45-degree field of view · color fundus photograph:
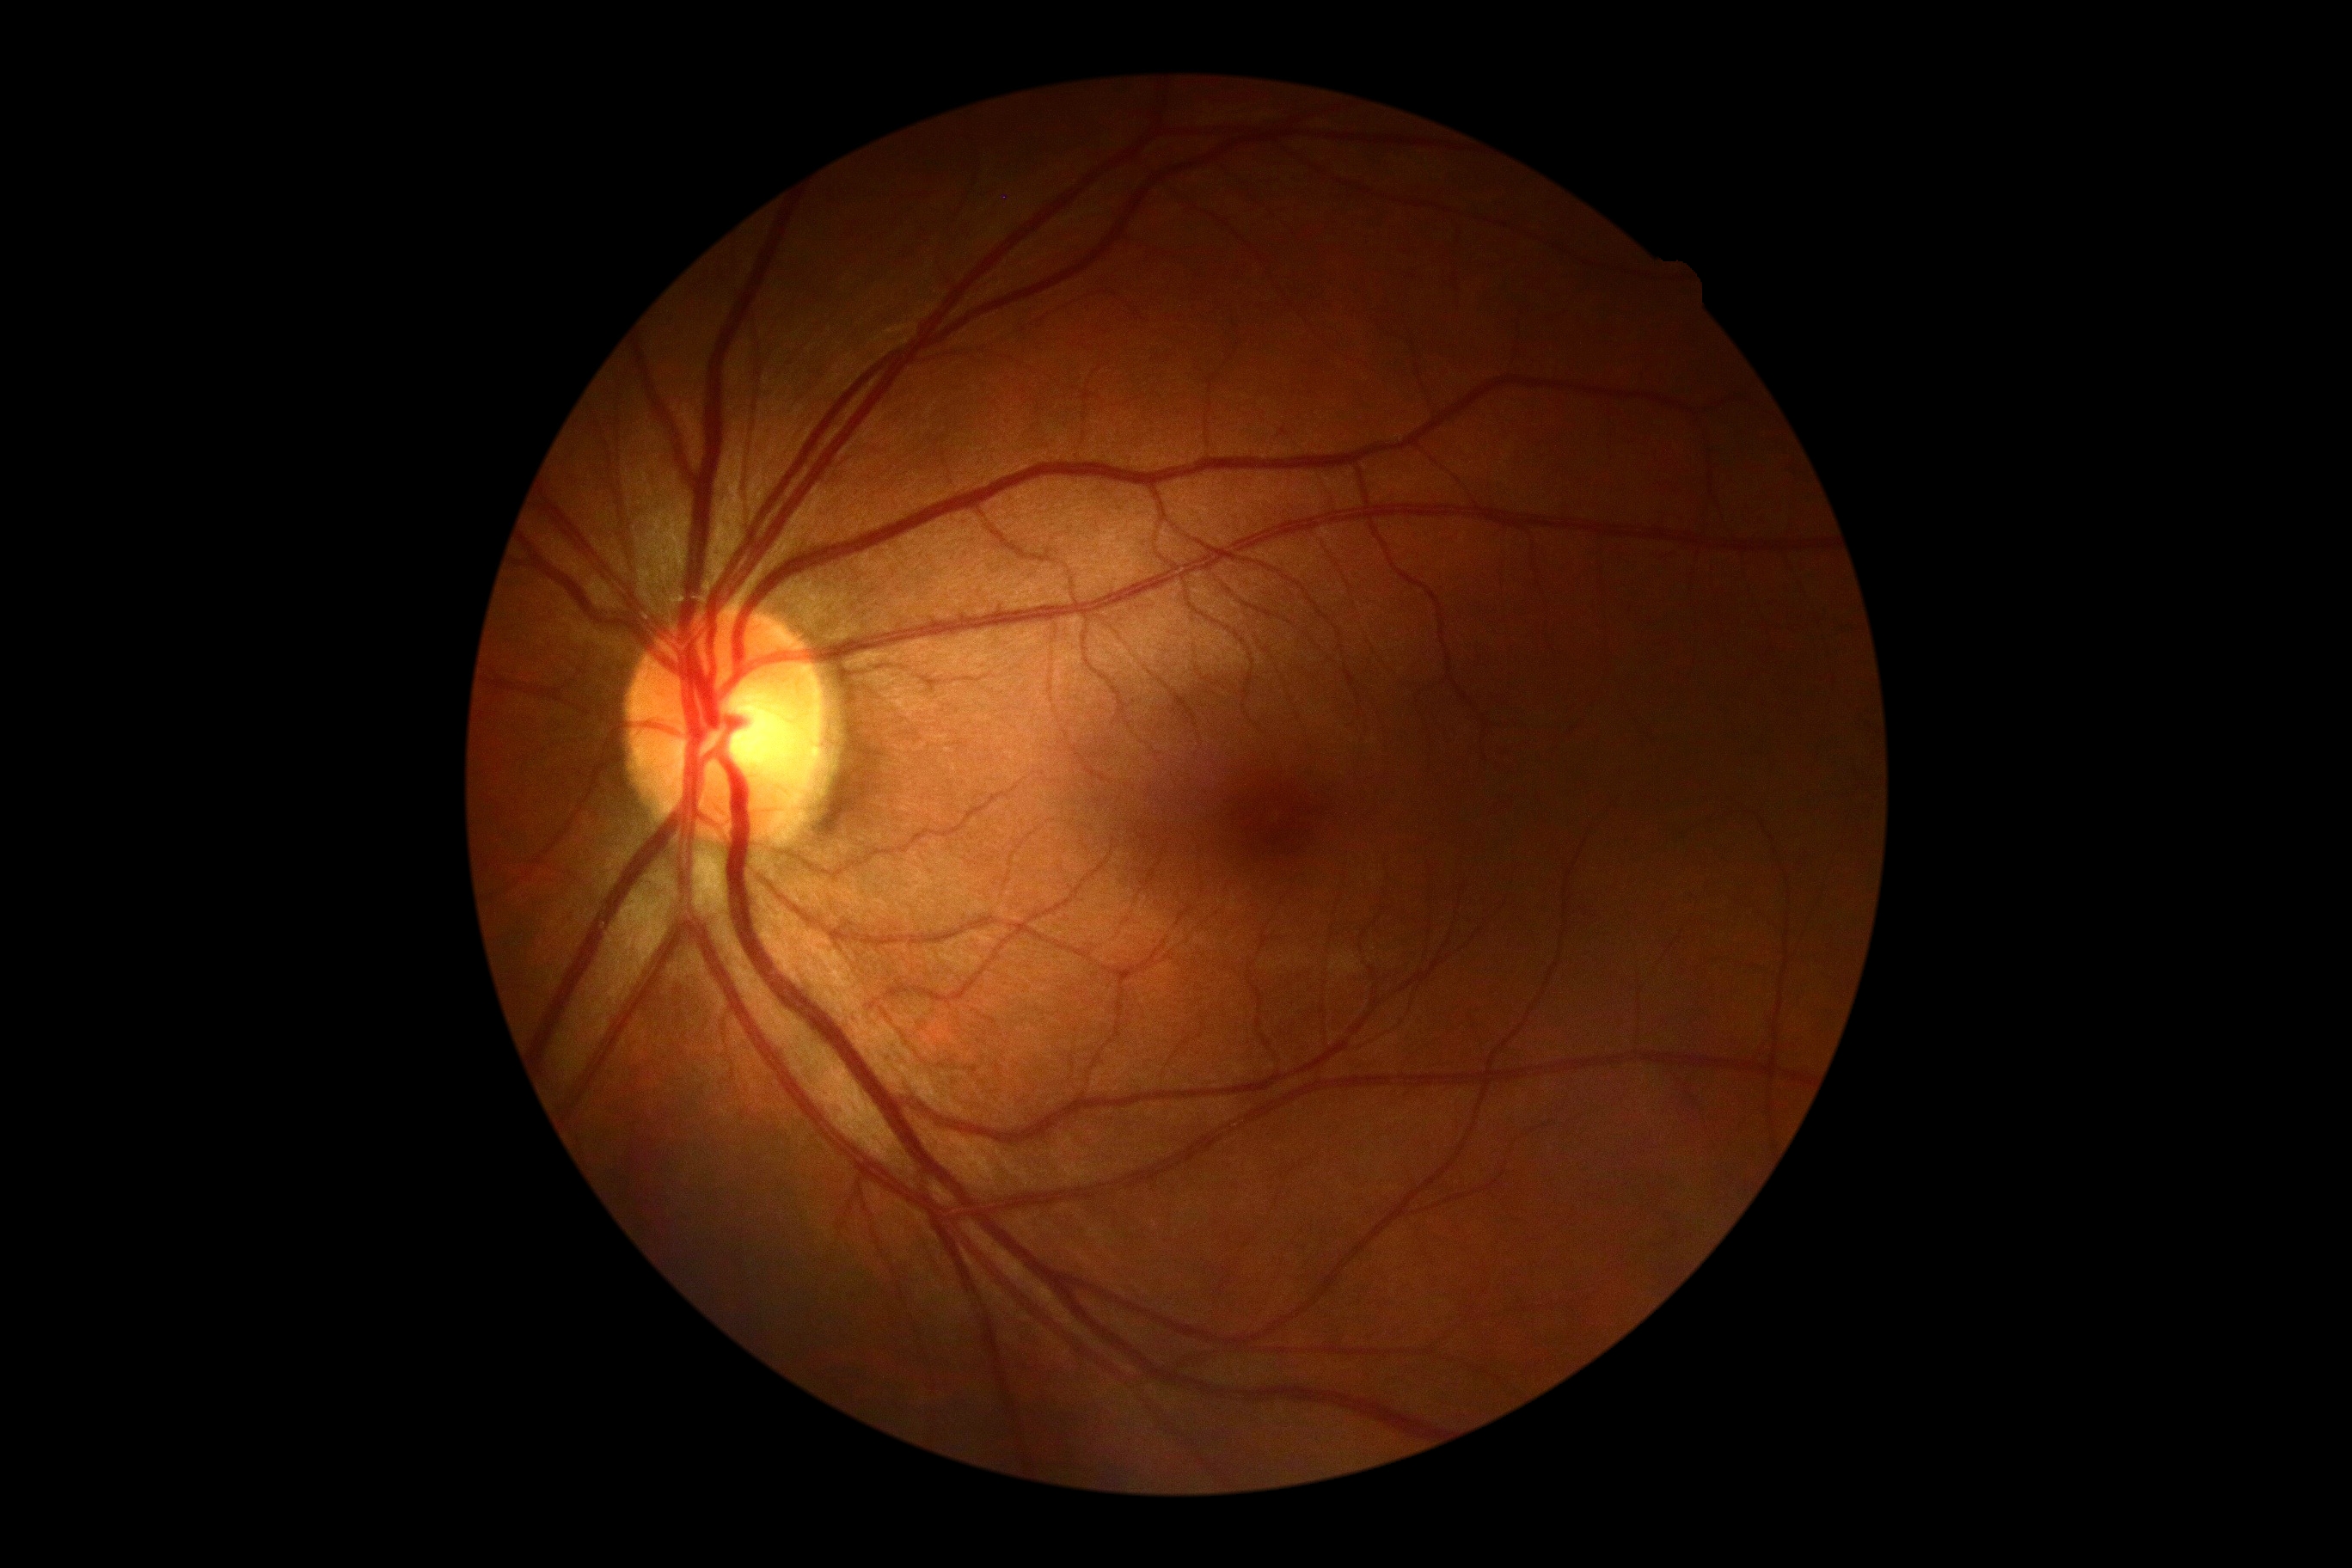

No DR findings. Diabetic retinopathy (DR) is no apparent diabetic retinopathy (grade 0) — no visible signs of diabetic retinopathy.